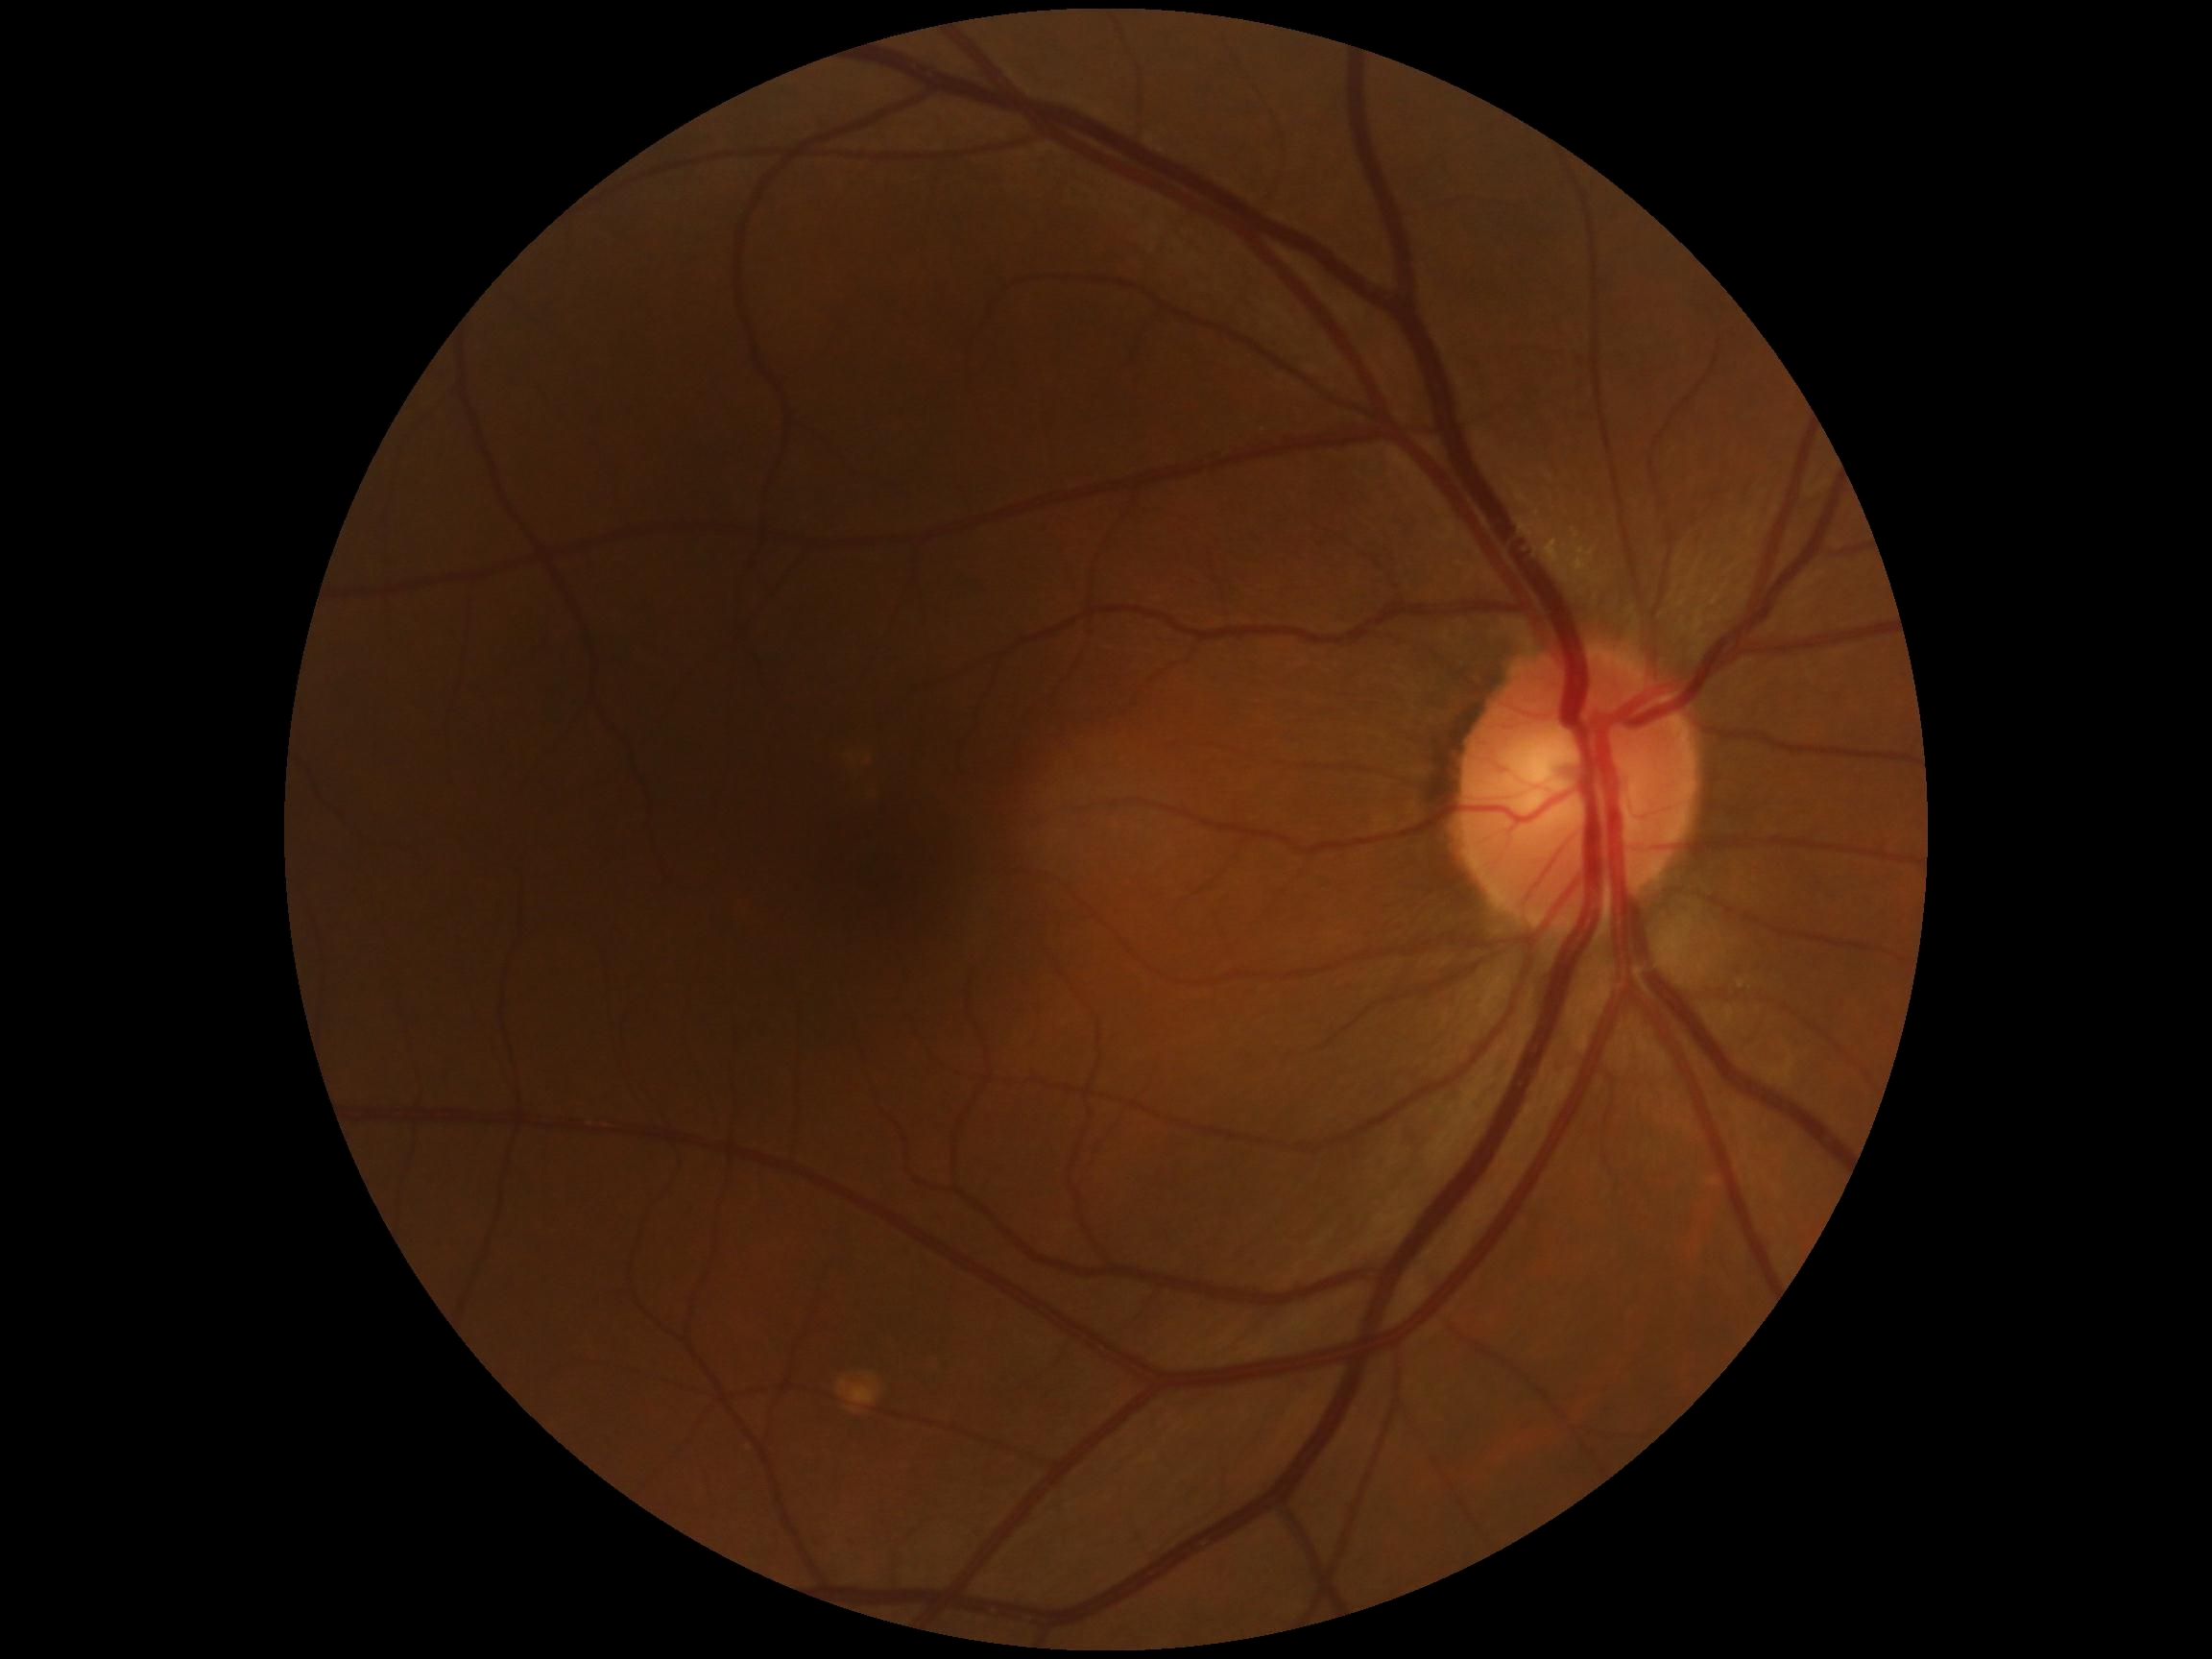

DR: no apparent retinopathy (grade 0) — no visible signs of diabetic retinopathy.